45 degree fundus photograph. Color fundus photograph.
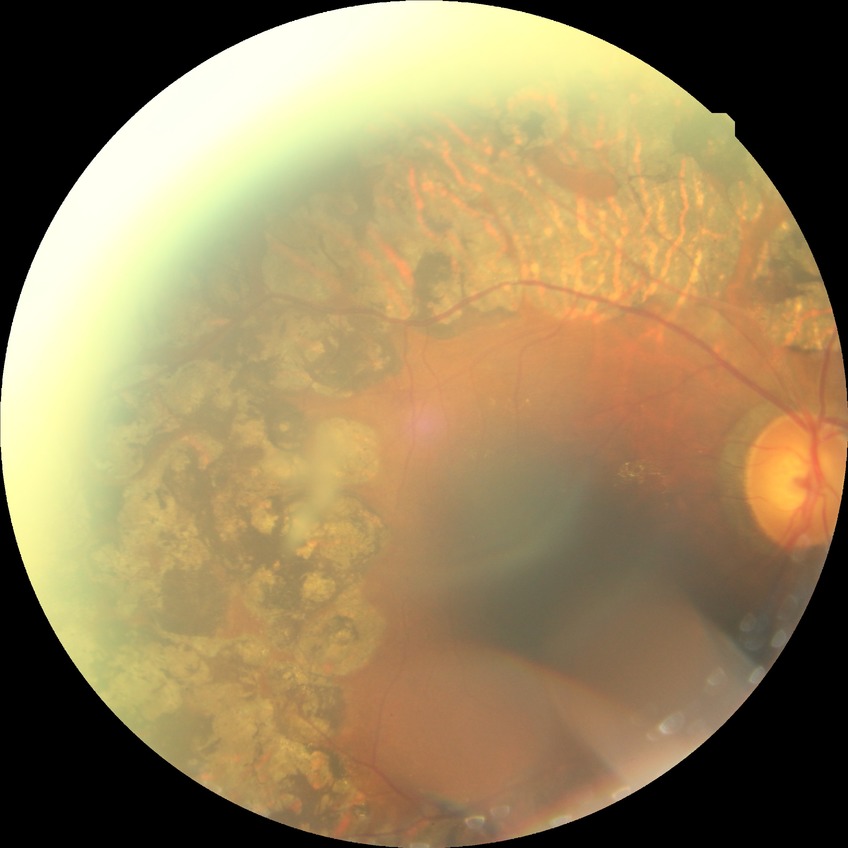

Modified Davis grading is proliferative diabetic retinopathy.